Wide-field fundus photograph from neonatal ROP screening.
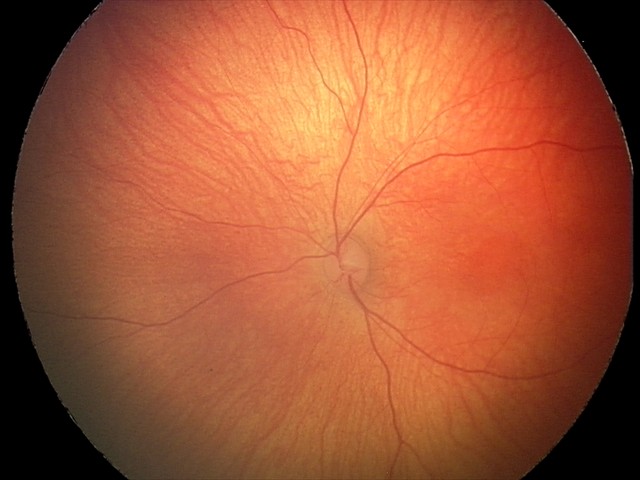

Diagnosis: normal